Wide-field fundus image from infant ROP screening; acquired on the Natus RetCam Envision — 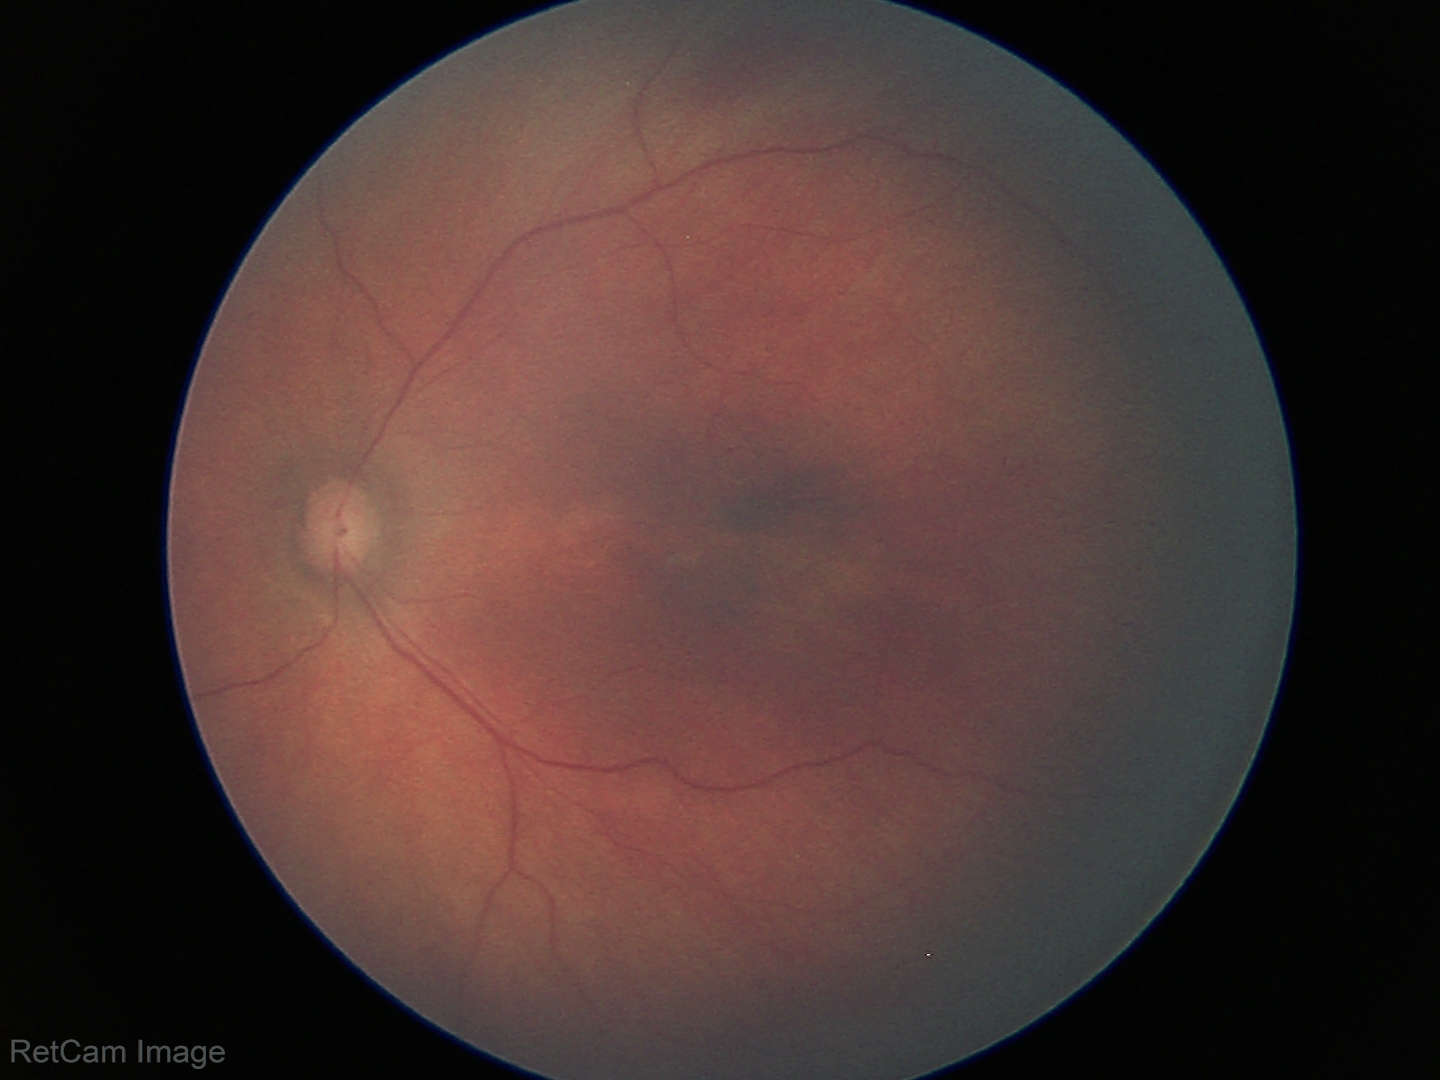

Diagnosis: no abnormalities.